Sex: F; axial length 22.72 mm; 68-year-old patient: 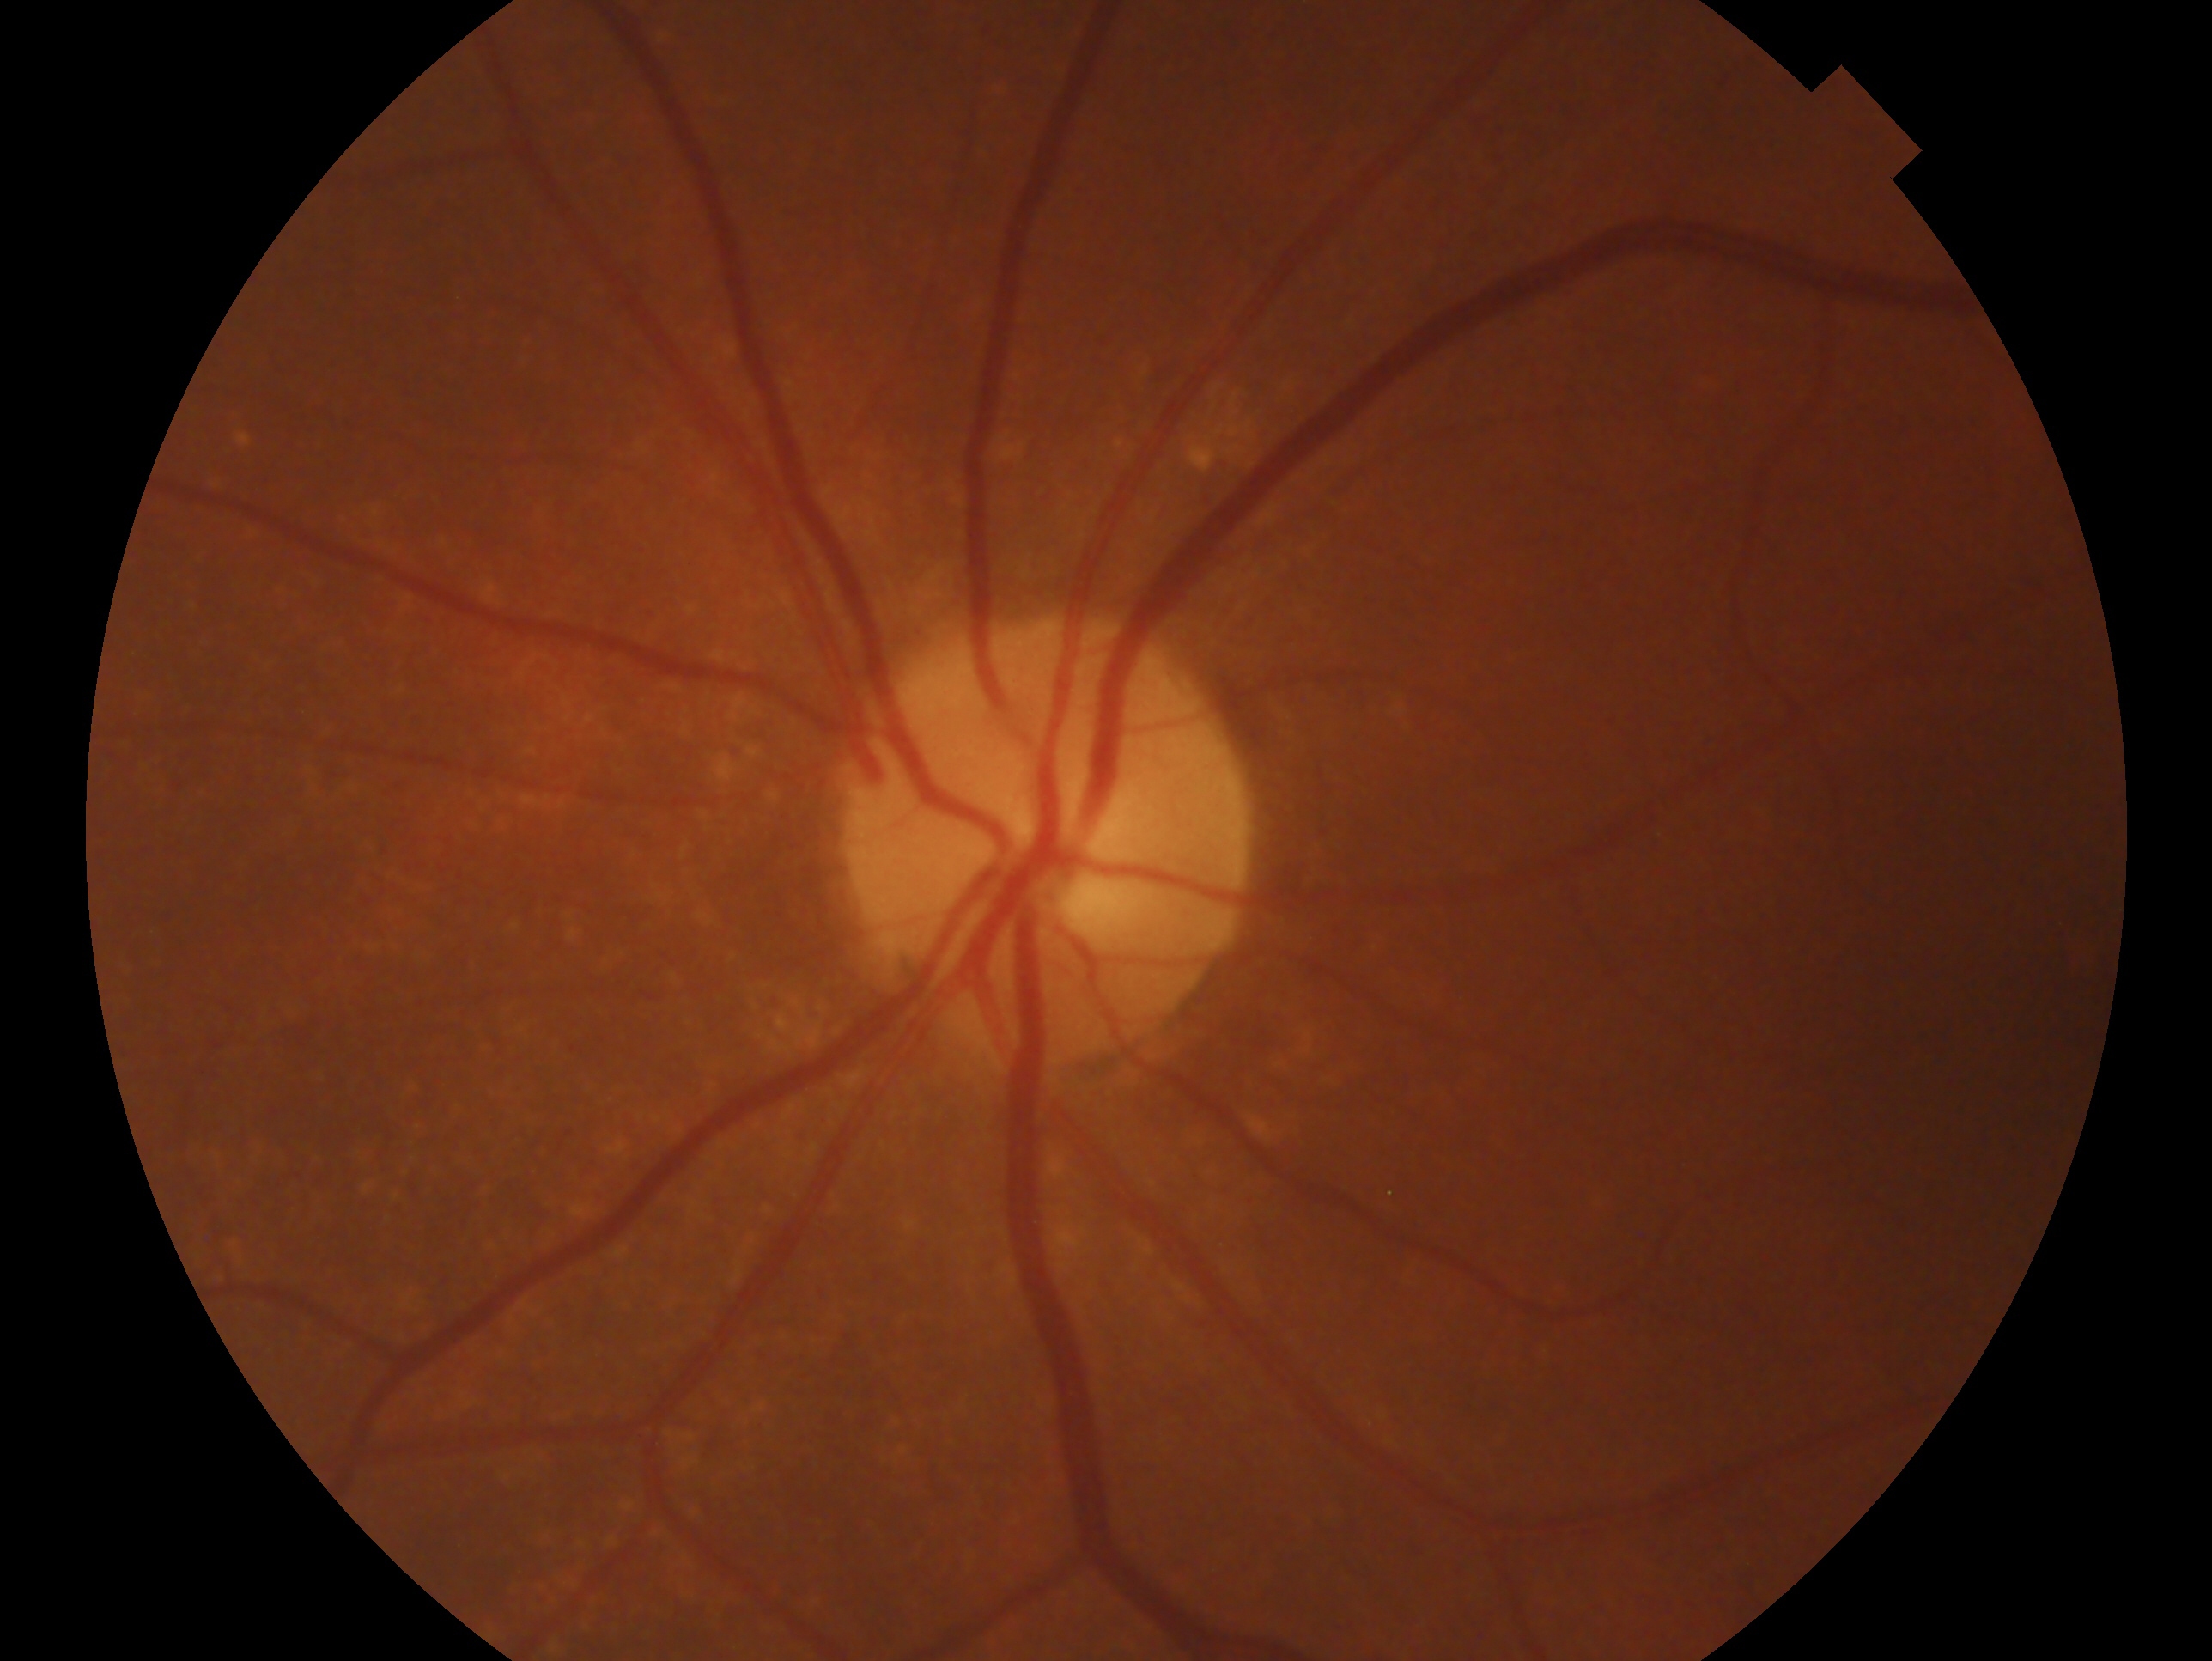
Q: Which eye is imaged?
A: left eye
Q: Glaucoma assessment?
A: negative for glaucoma — no clinical evidence of glaucoma in this eye